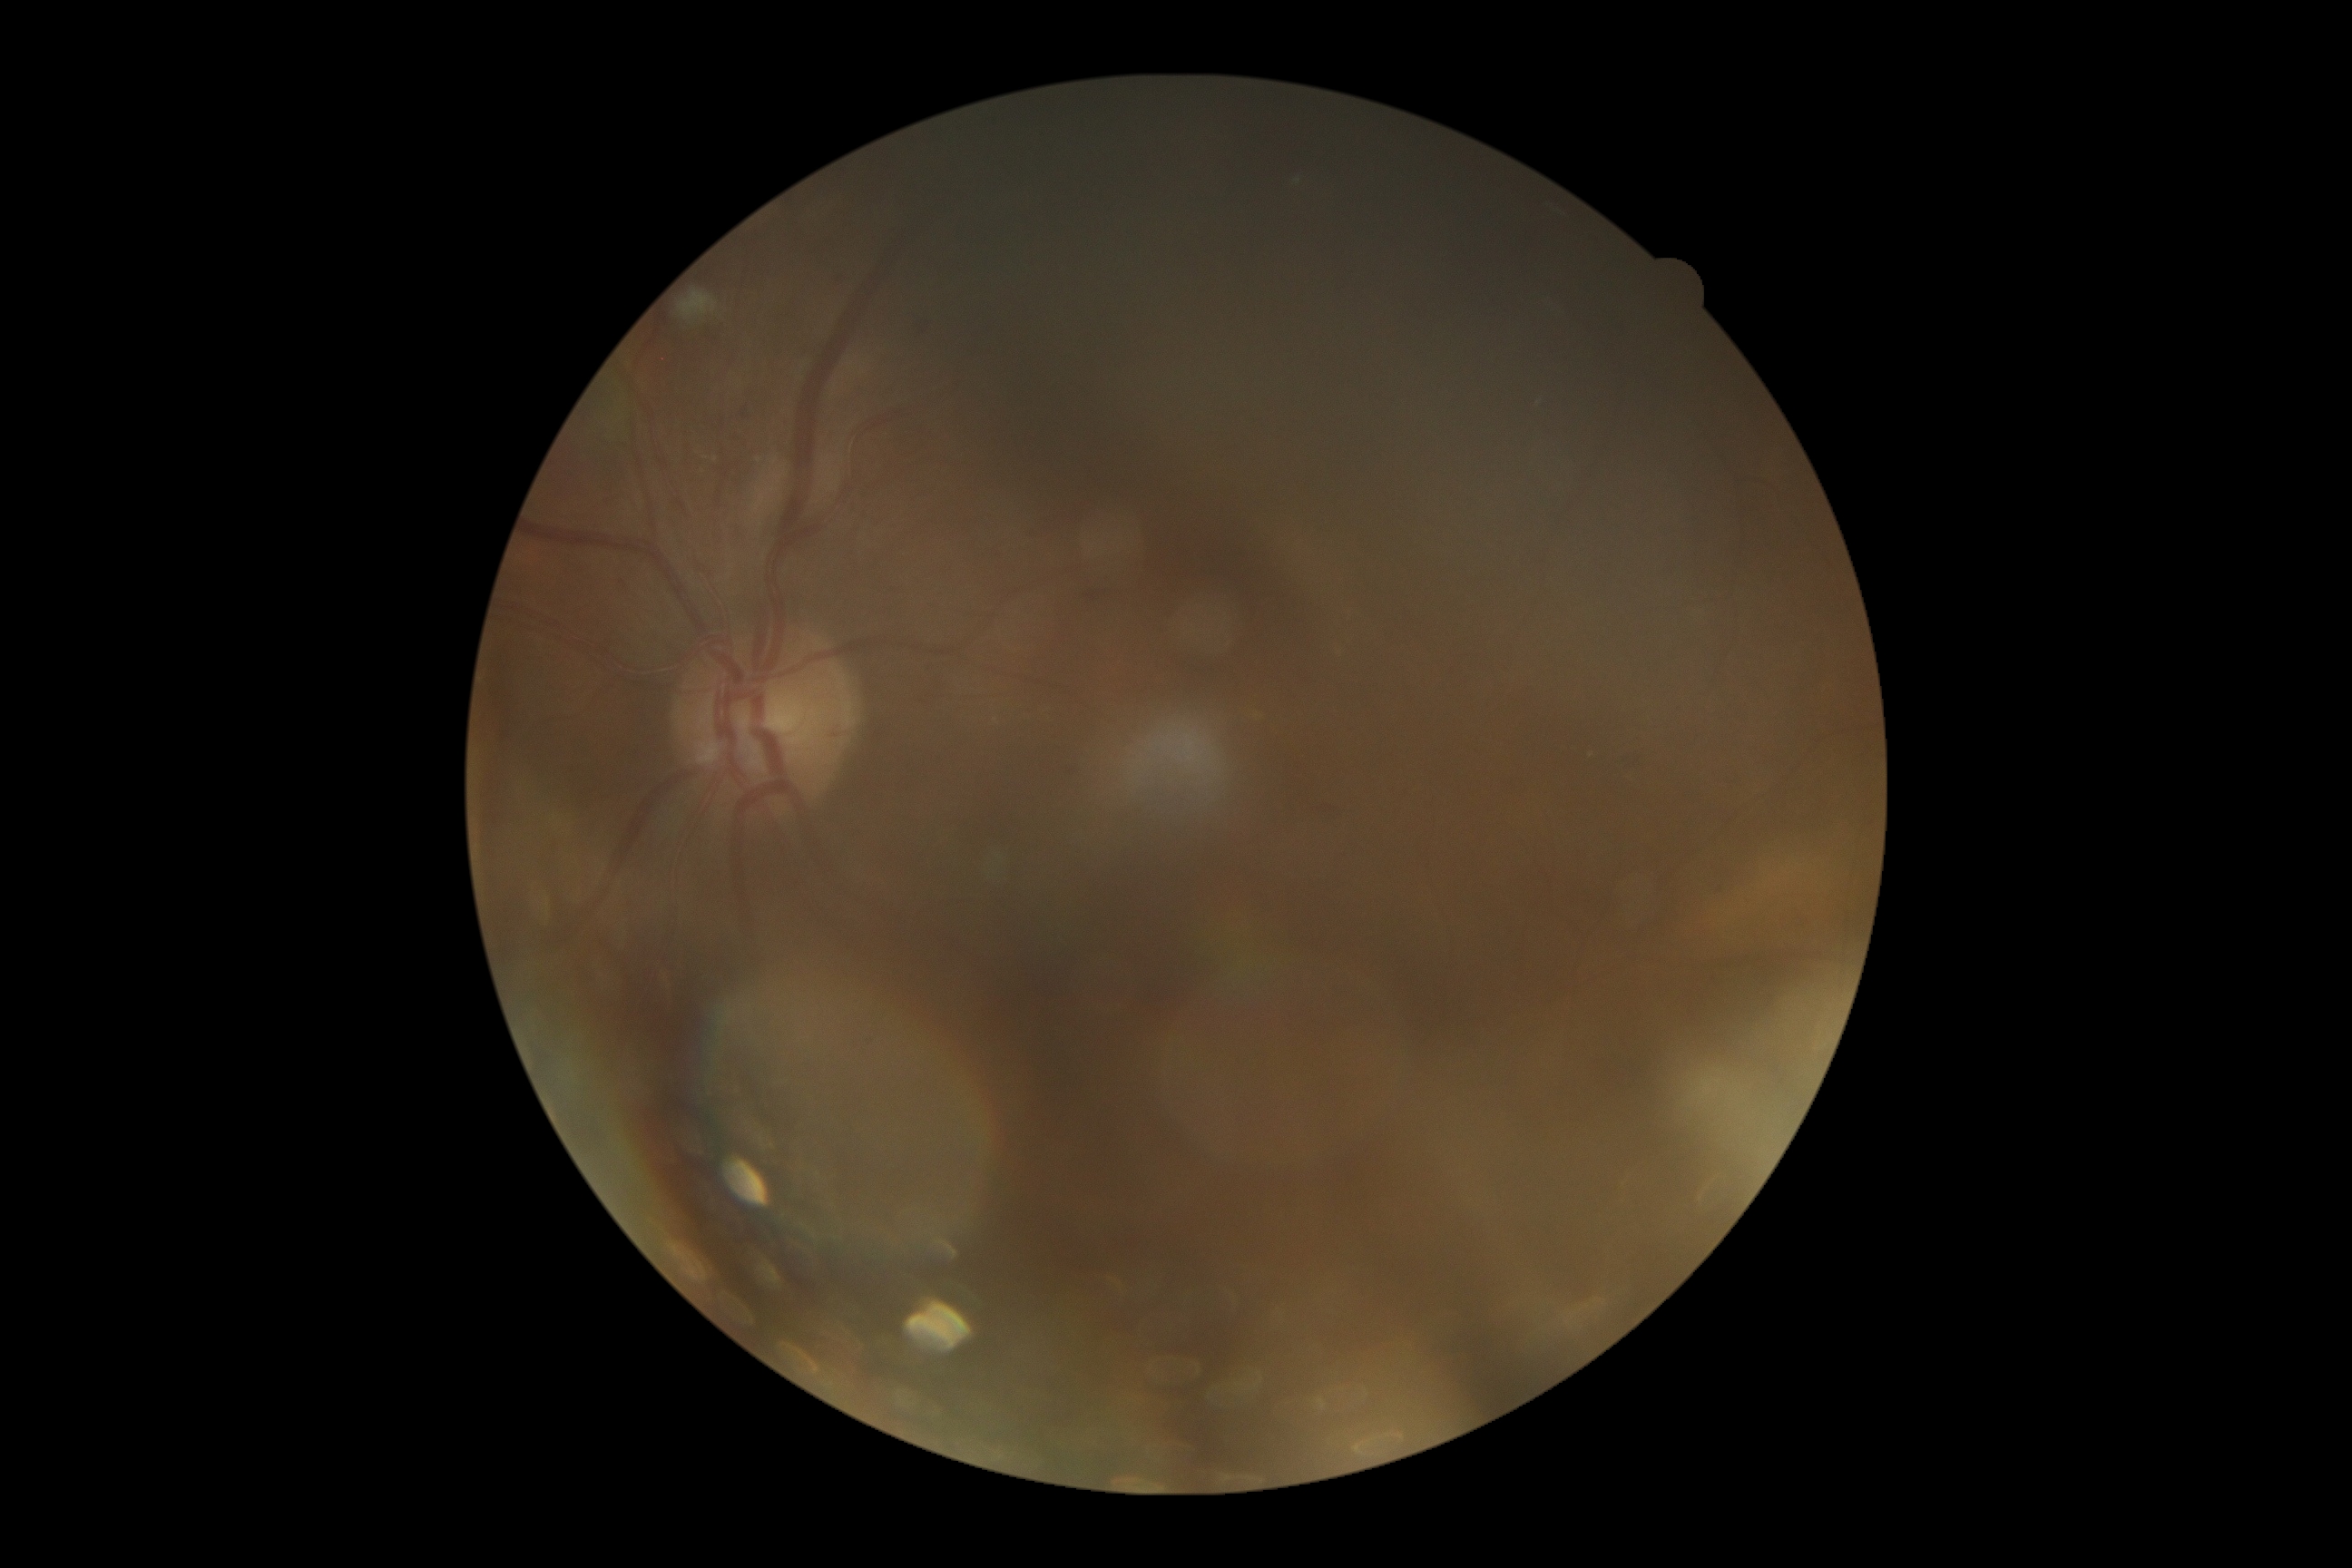
* diabetic retinopathy (DR) — grade 2
* DR class — non-proliferative diabetic retinopathy